848 x 848 pixels. Camera: NIDEK AFC-230. Modified Davis grading
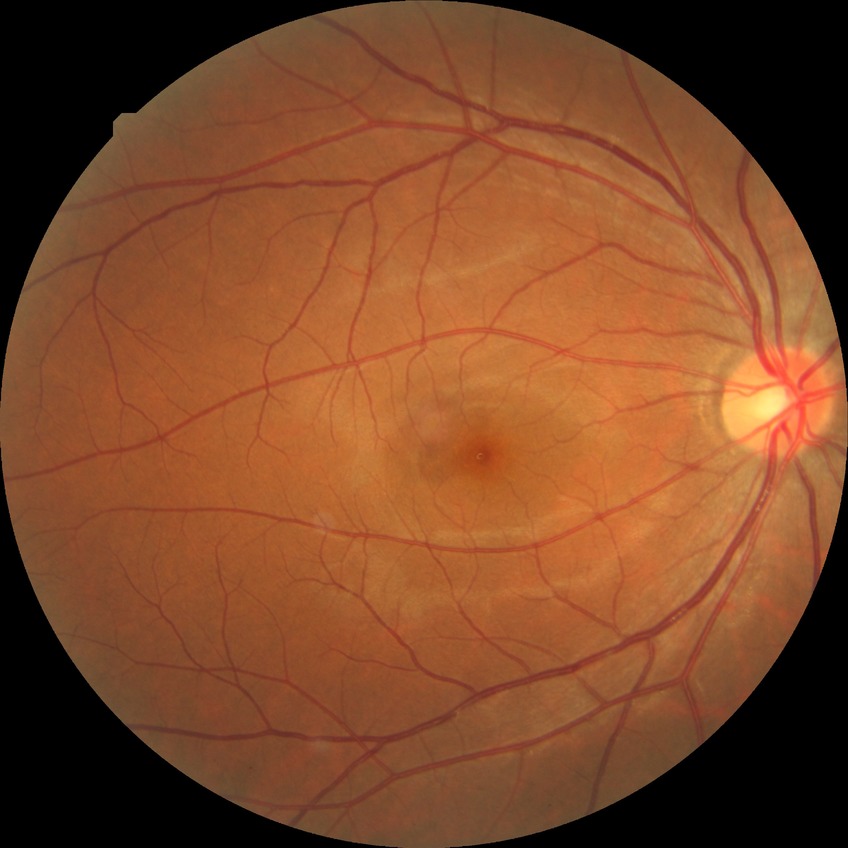
davis_grade: NDR
dr_impression: no DR findings